Wide-field fundus image from infant ROP screening. Acquired on the Clarity RetCam 3. 640 x 480 pixels.
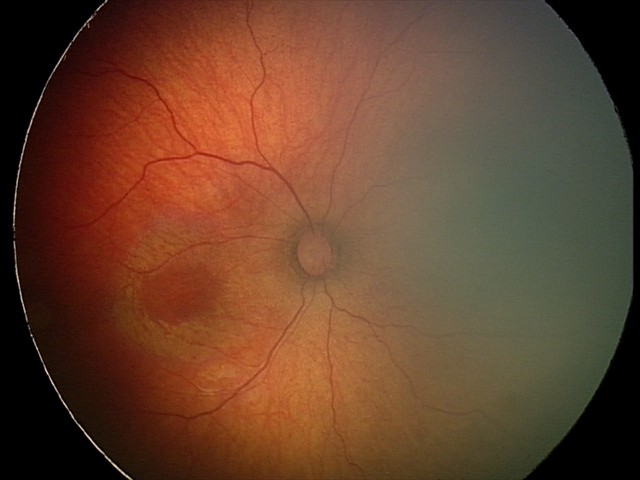 From an examination with diagnosis of status post retinopathy of prematurity (ROP).
Without plus disease.